Wide-field contact fundus photograph of an infant: 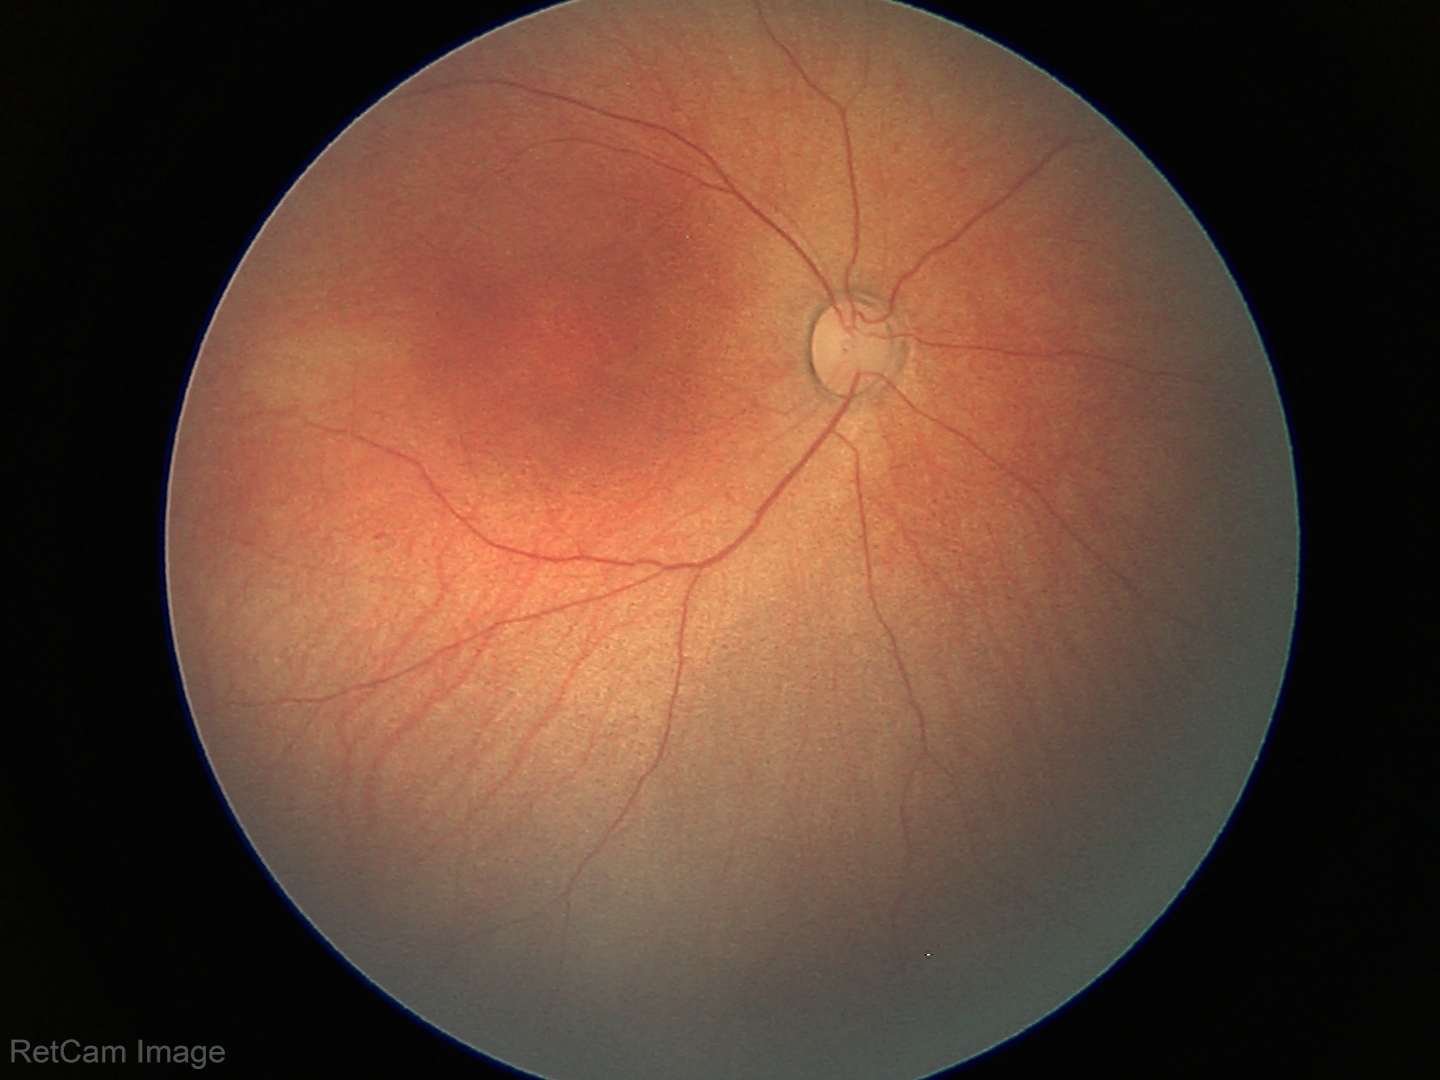
Physiological retinal appearance for postconceptual age.